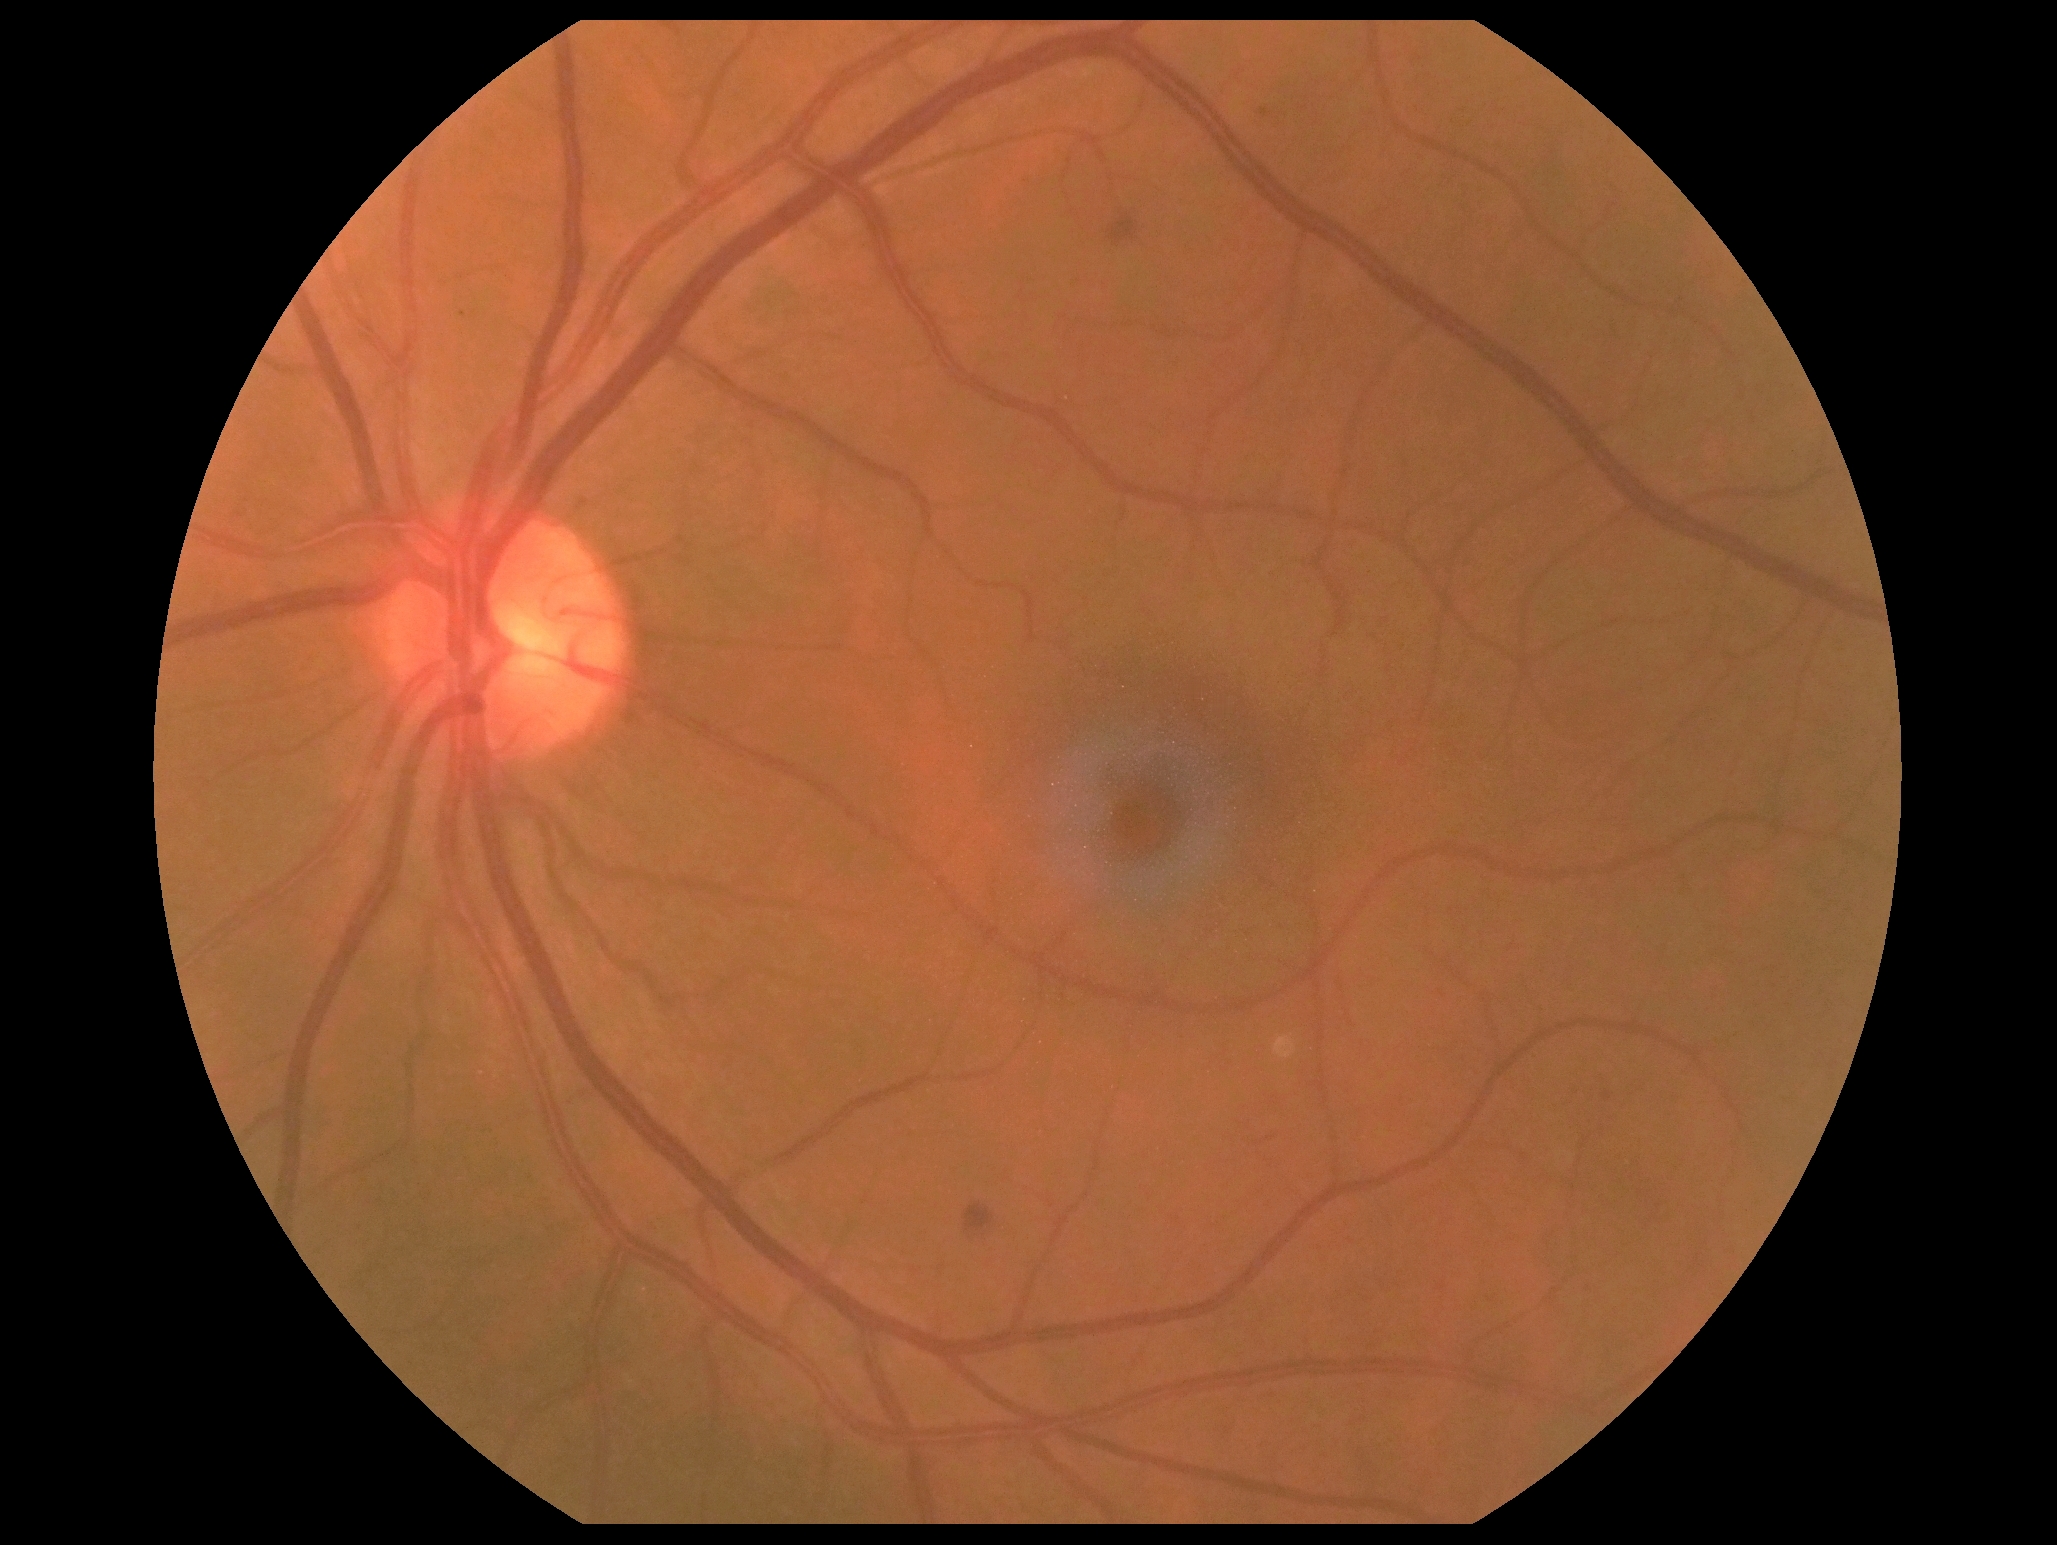

DR class: non-proliferative diabetic retinopathy; DR: 2.